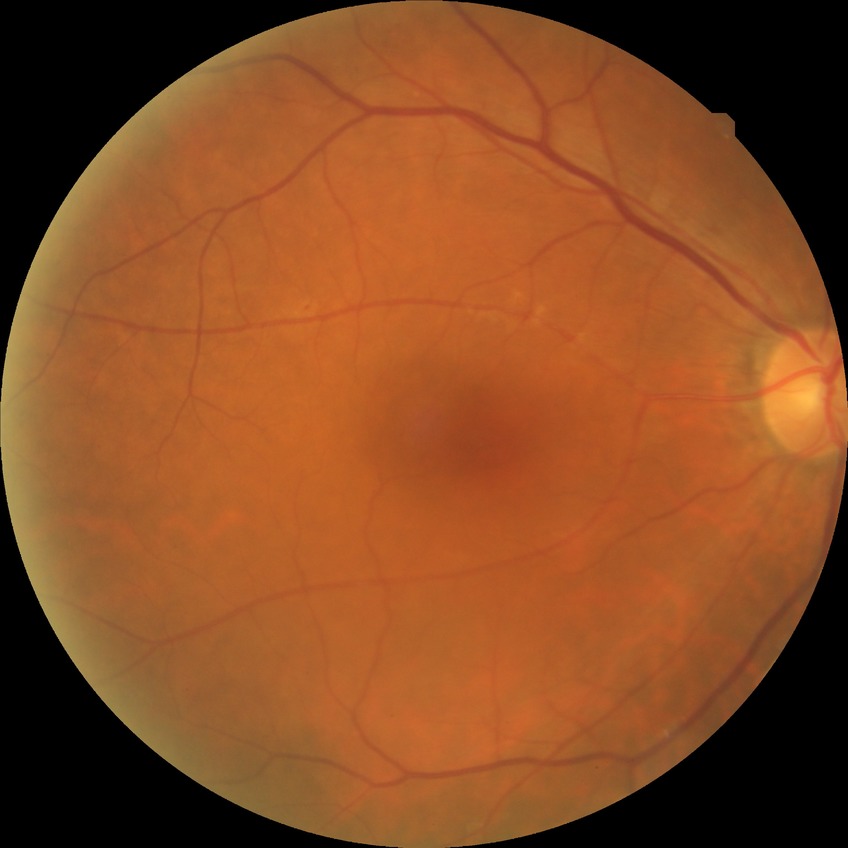

Davis grade is SDR.